Pediatric retinal photograph (wide-field). Acquired on the Phoenix ICON
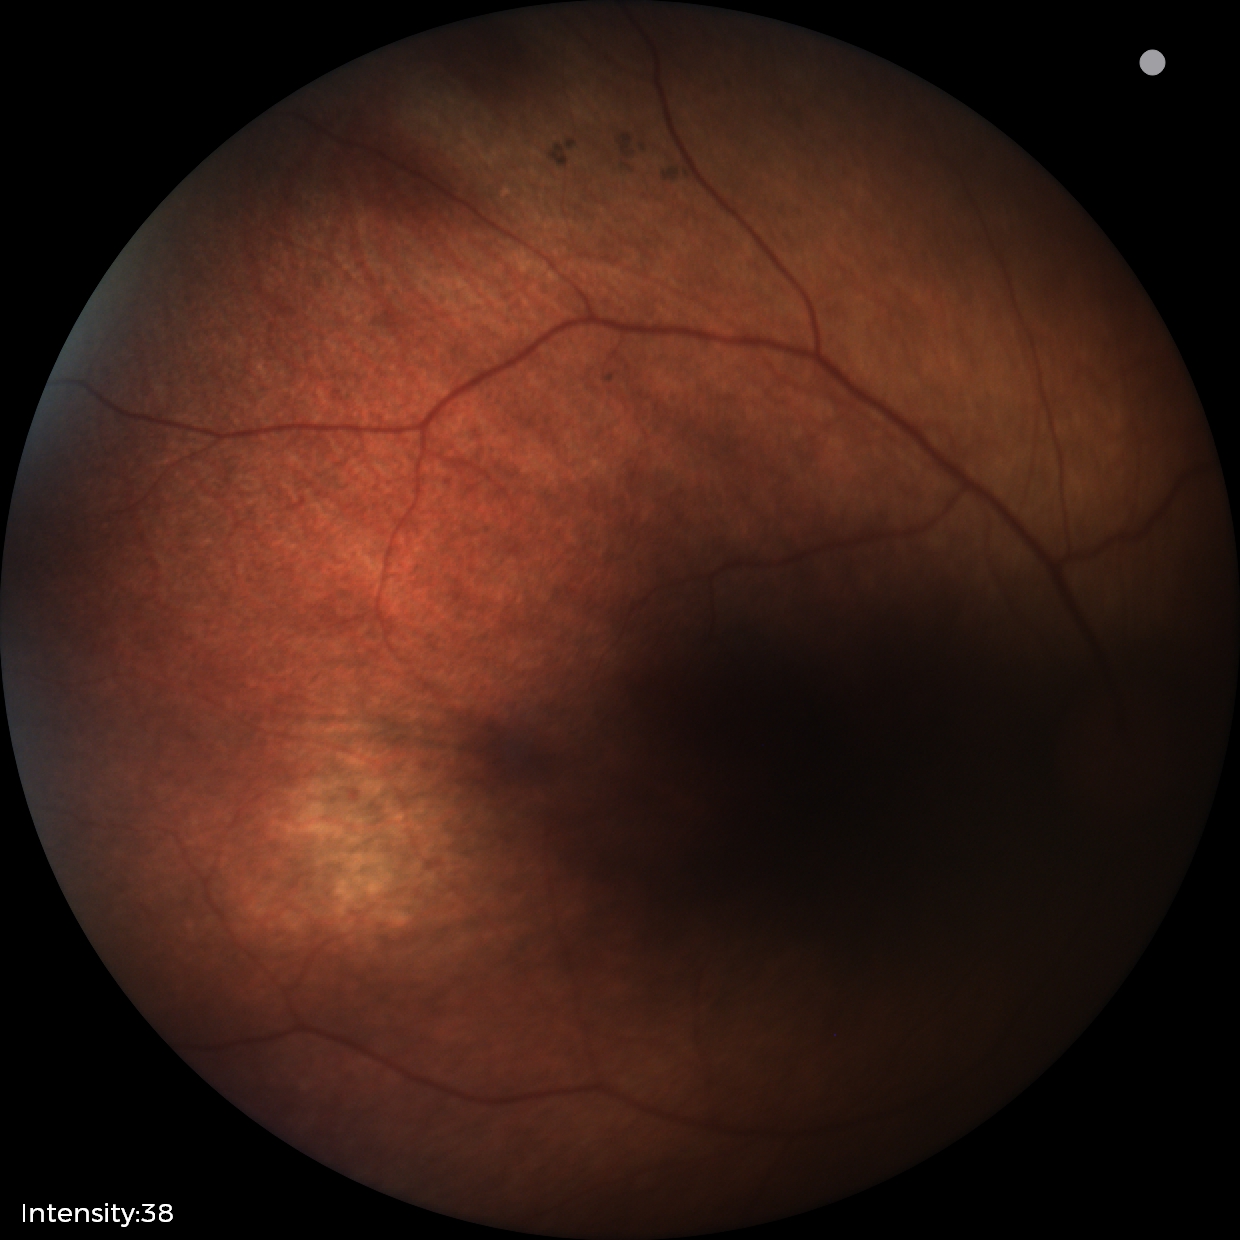

No retinal pathology identified on screening.